Nonmydriatic fundus photograph; fundus photo; NIDEK AFC-230 fundus camera.
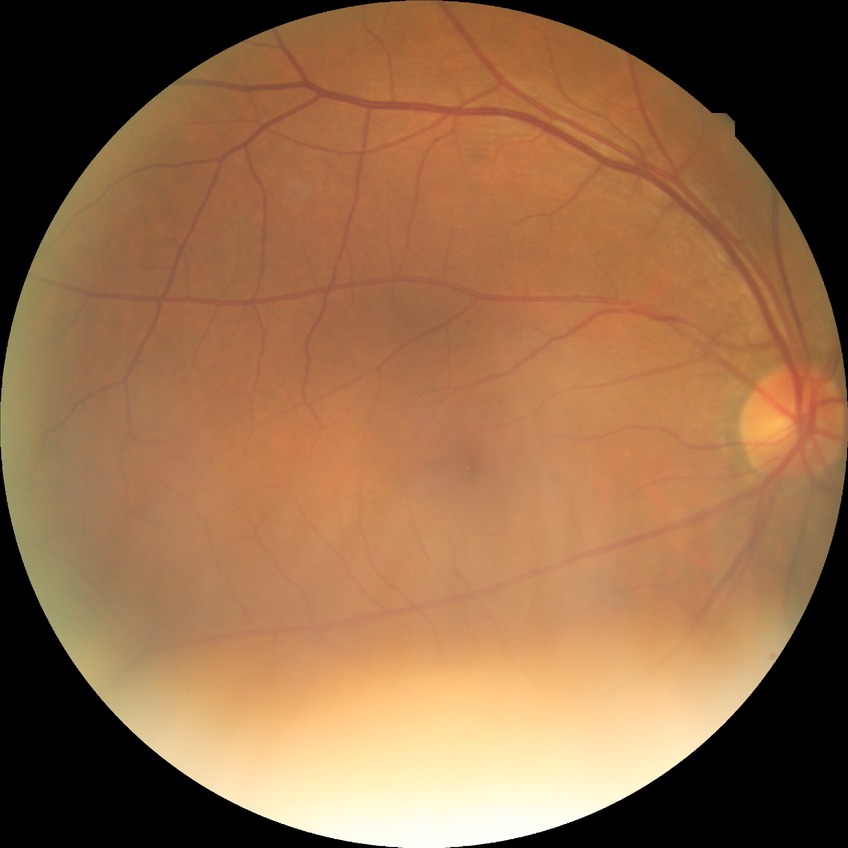
Diabetic retinopathy (DR) is no diabetic retinopathy (NDR).